Image size 640x480; pediatric retinal photograph (wide-field)
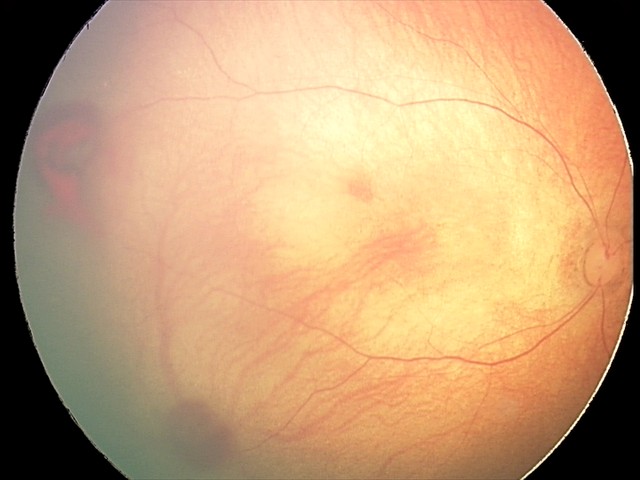

Assessment: retinal hemorrhages.